NIDEK AFC-230 fundus camera.
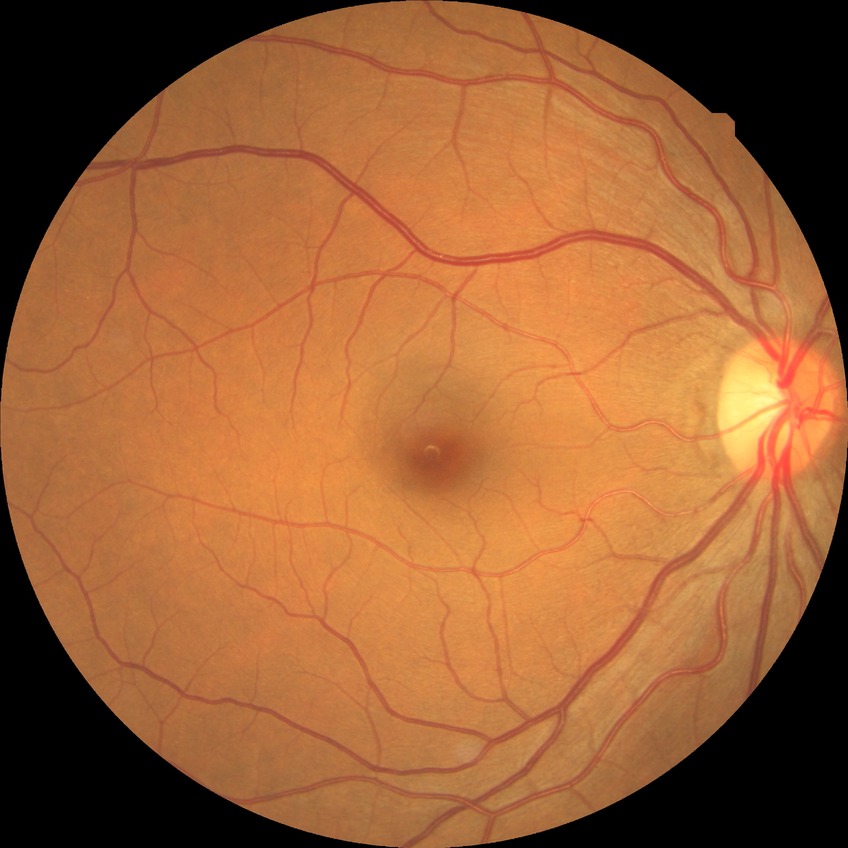

Diabetic retinopathy severity: no diabetic retinopathy.